Modified Davis classification. Nonmydriatic.
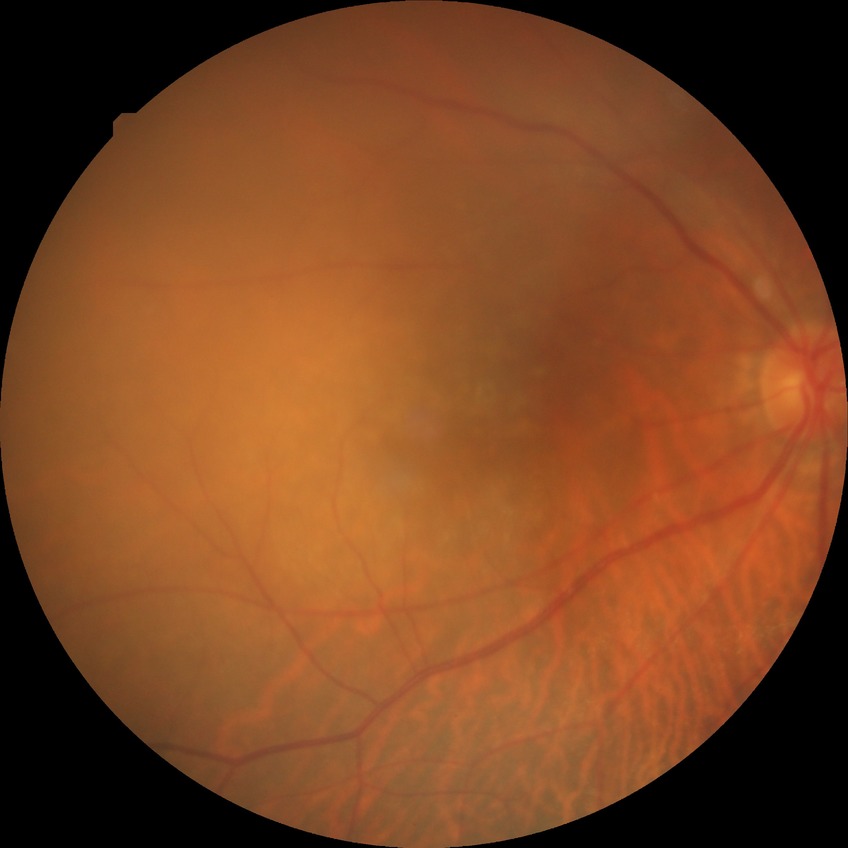

diabetic retinopathy (DR): no diabetic retinopathy (NDR).